45-degree field of view. Davis DR grading. NIDEK AFC-230 fundus camera — 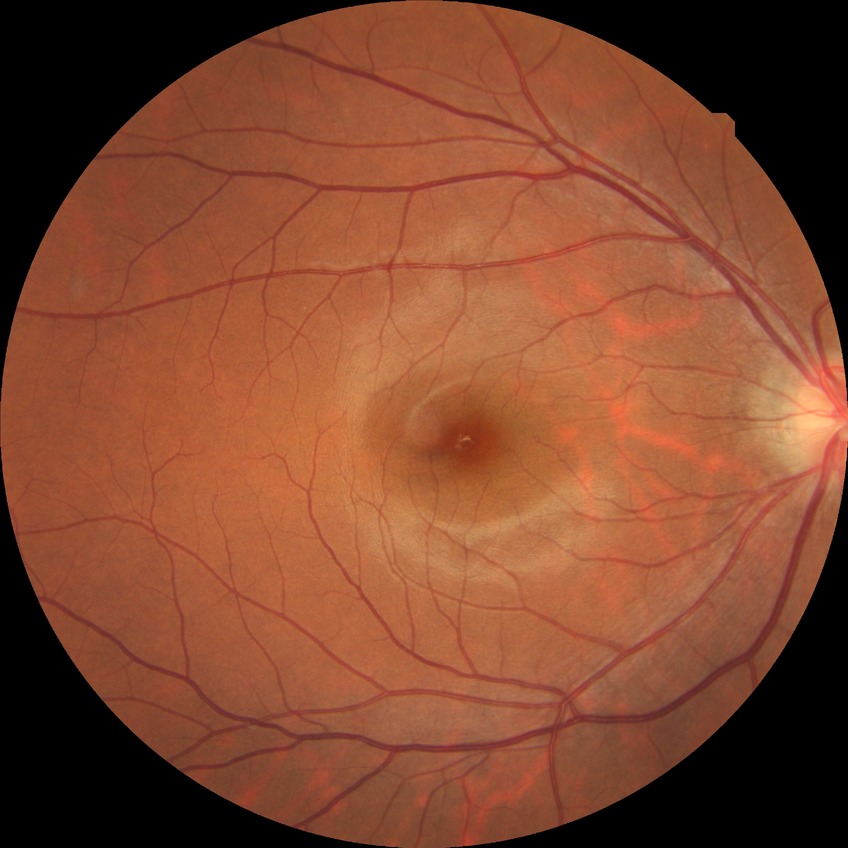

Diabetic retinopathy grade is no diabetic retinopathy.